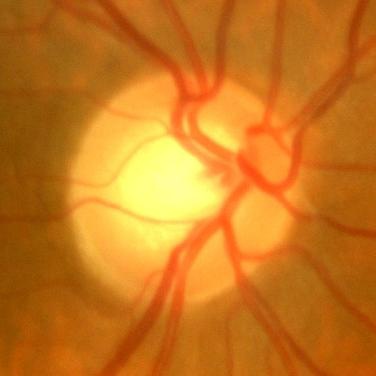 Glaucoma assessment = no signs of glaucoma.